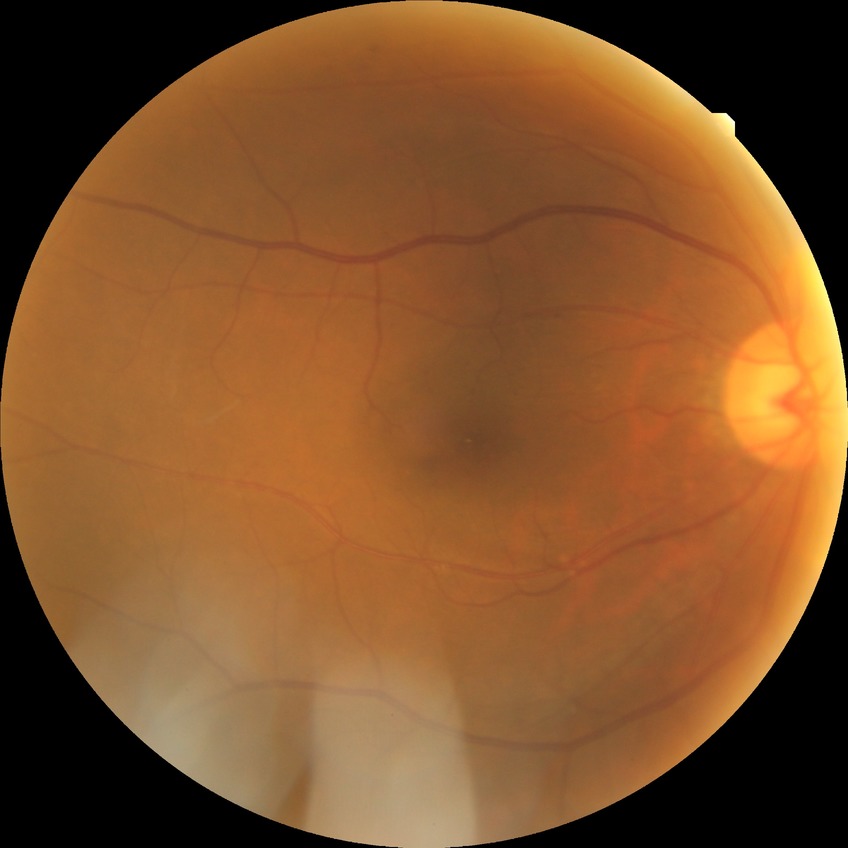 DR class=non-proliferative diabetic retinopathy; diabetic retinopathy (DR)=SDR (simple diabetic retinopathy).